DR severity per modified Davis staging: 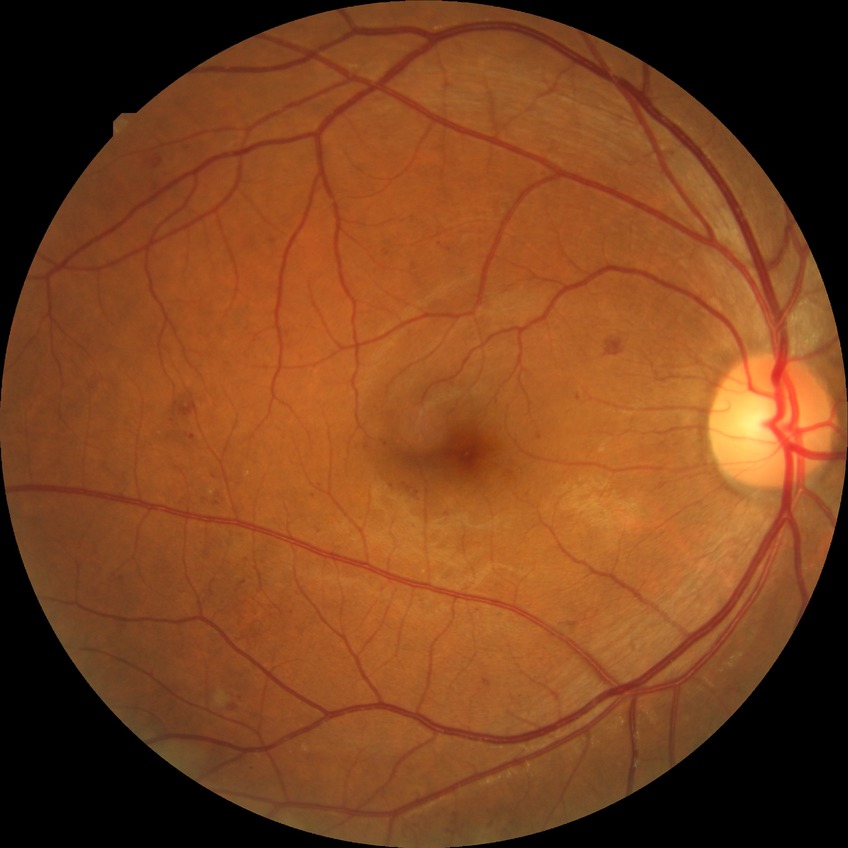

  davis_grade: simple diabetic retinopathy